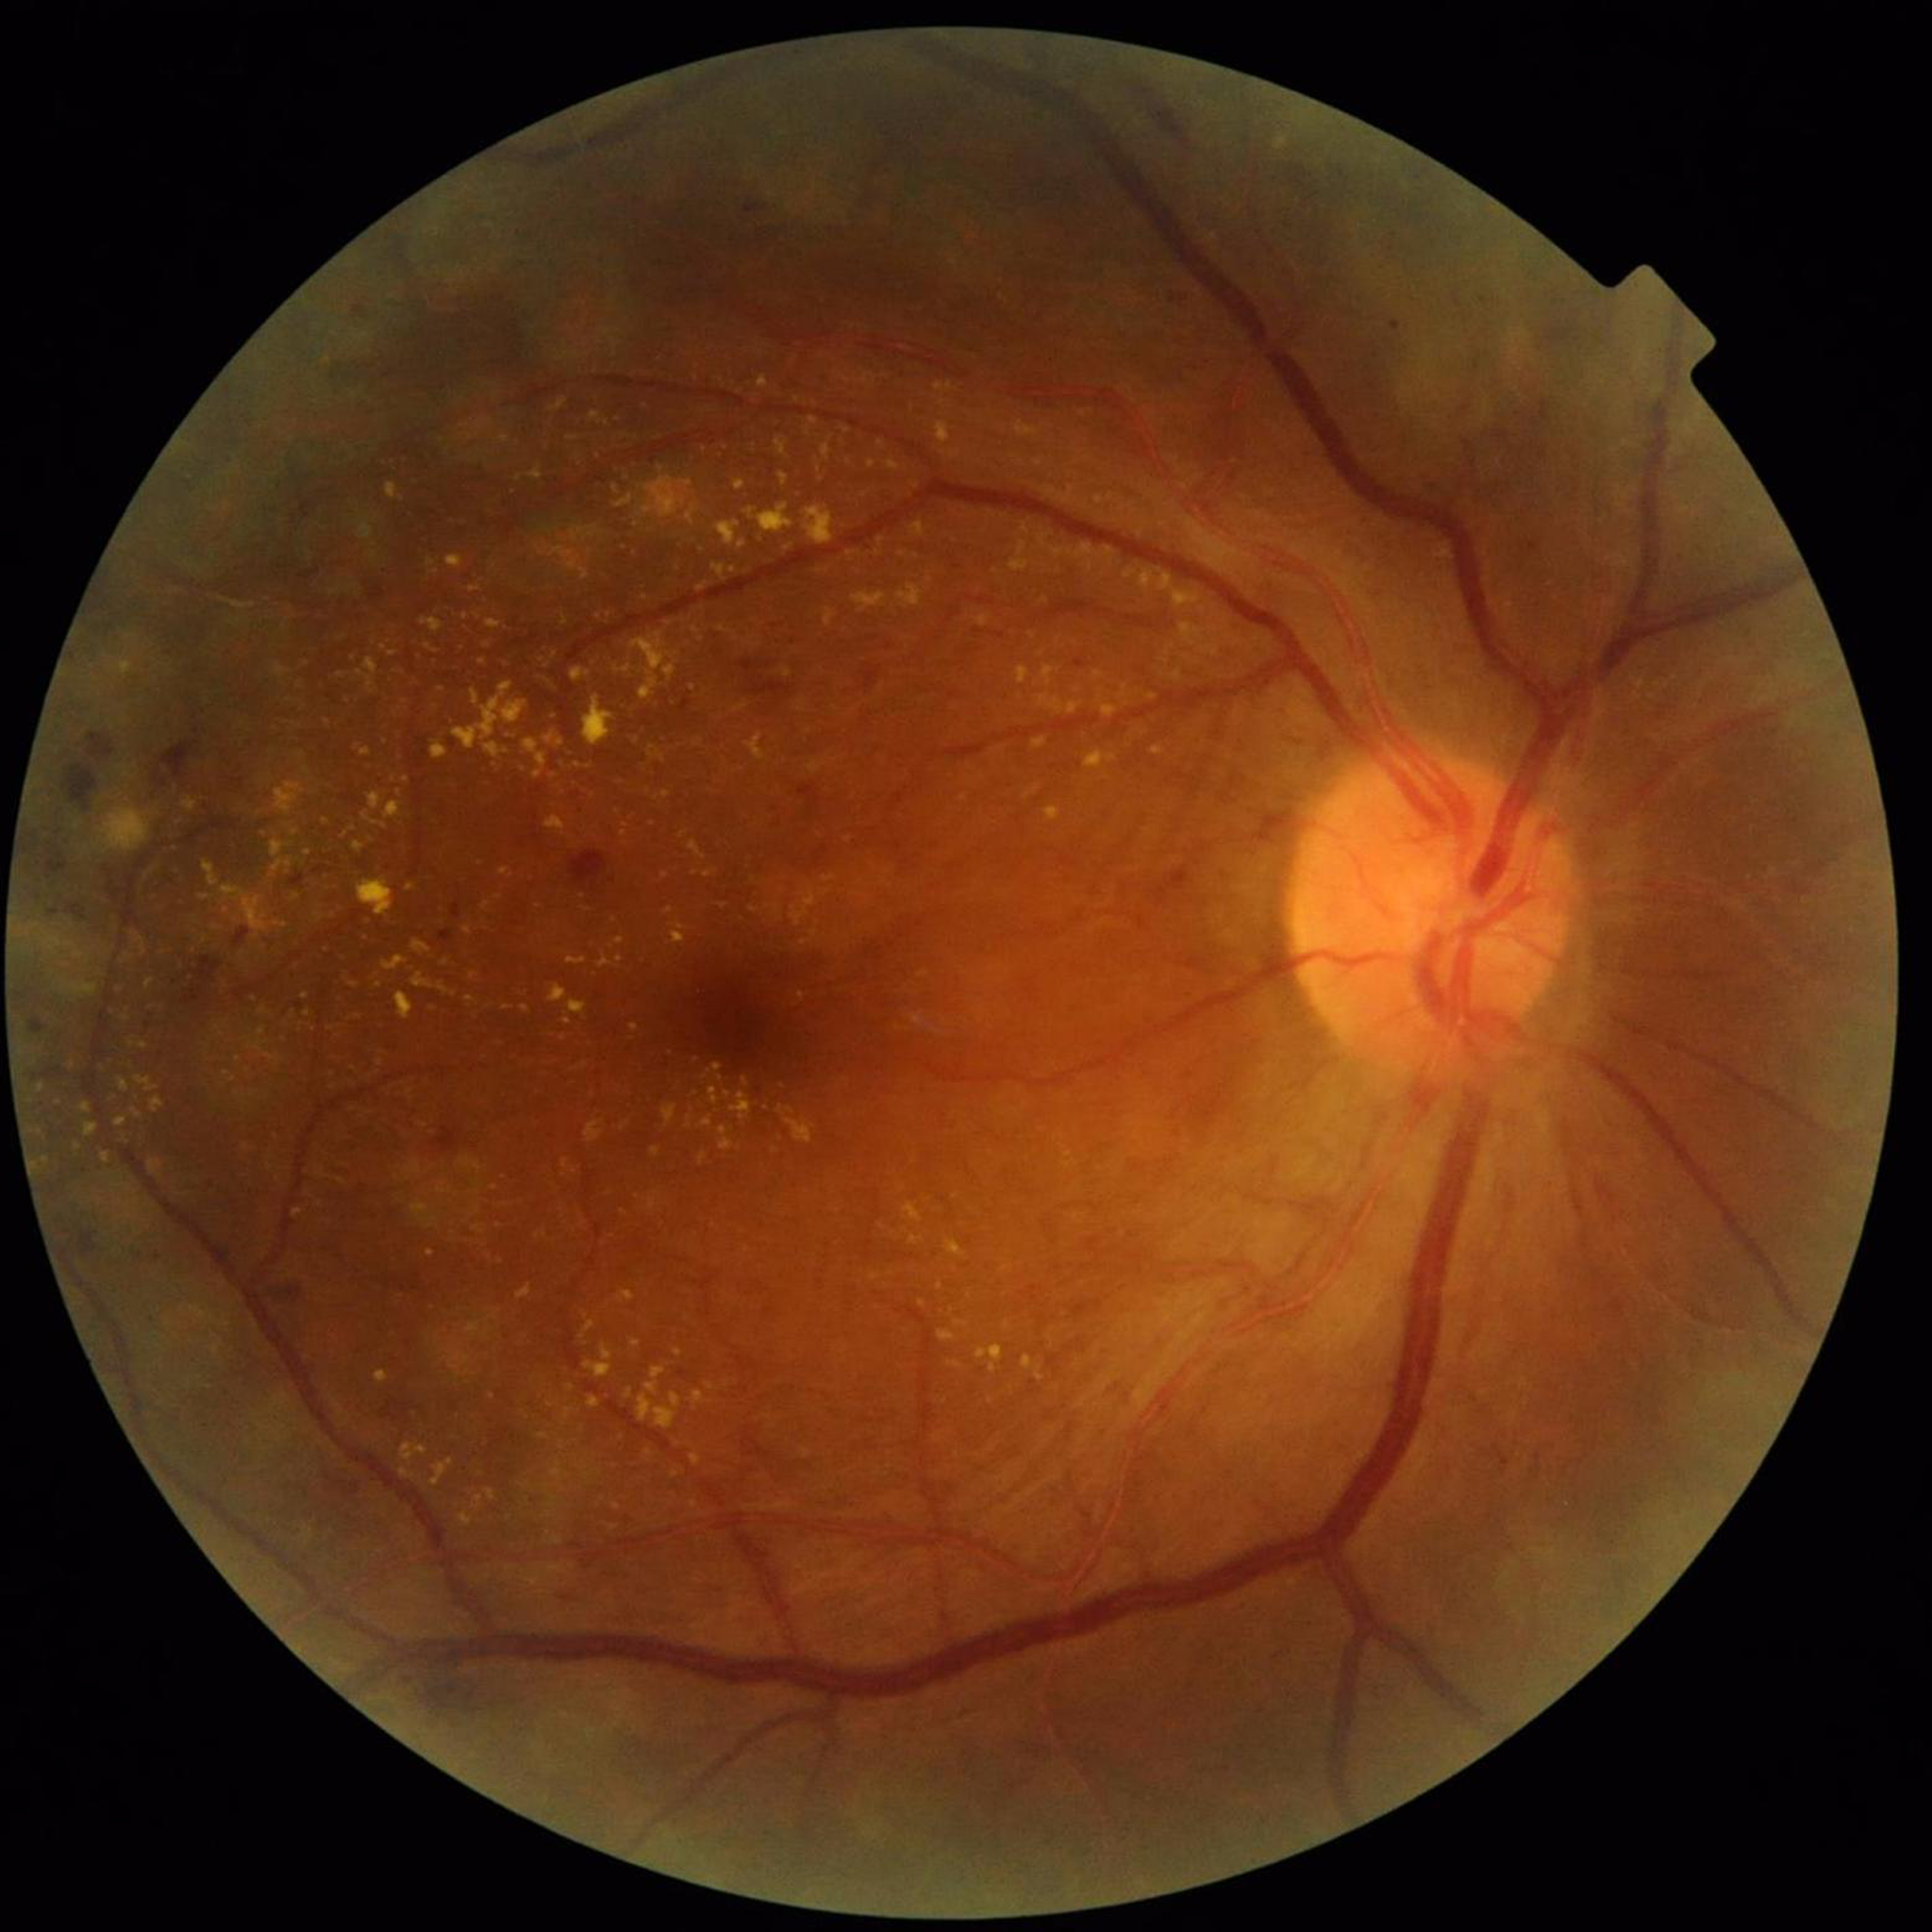
  diagnosis: diabetic retinopathy